Captured on a Nidek AFC-330 fundus camera; retinal fundus photograph: 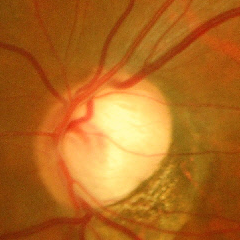
Findings consistent with glaucoma.
Advanced glaucomatous optic neuropathy.
Diagnostic criteria: near-total cupping of the optic nerve head, with or without severe visual field loss within the central 10 degrees of fixation.